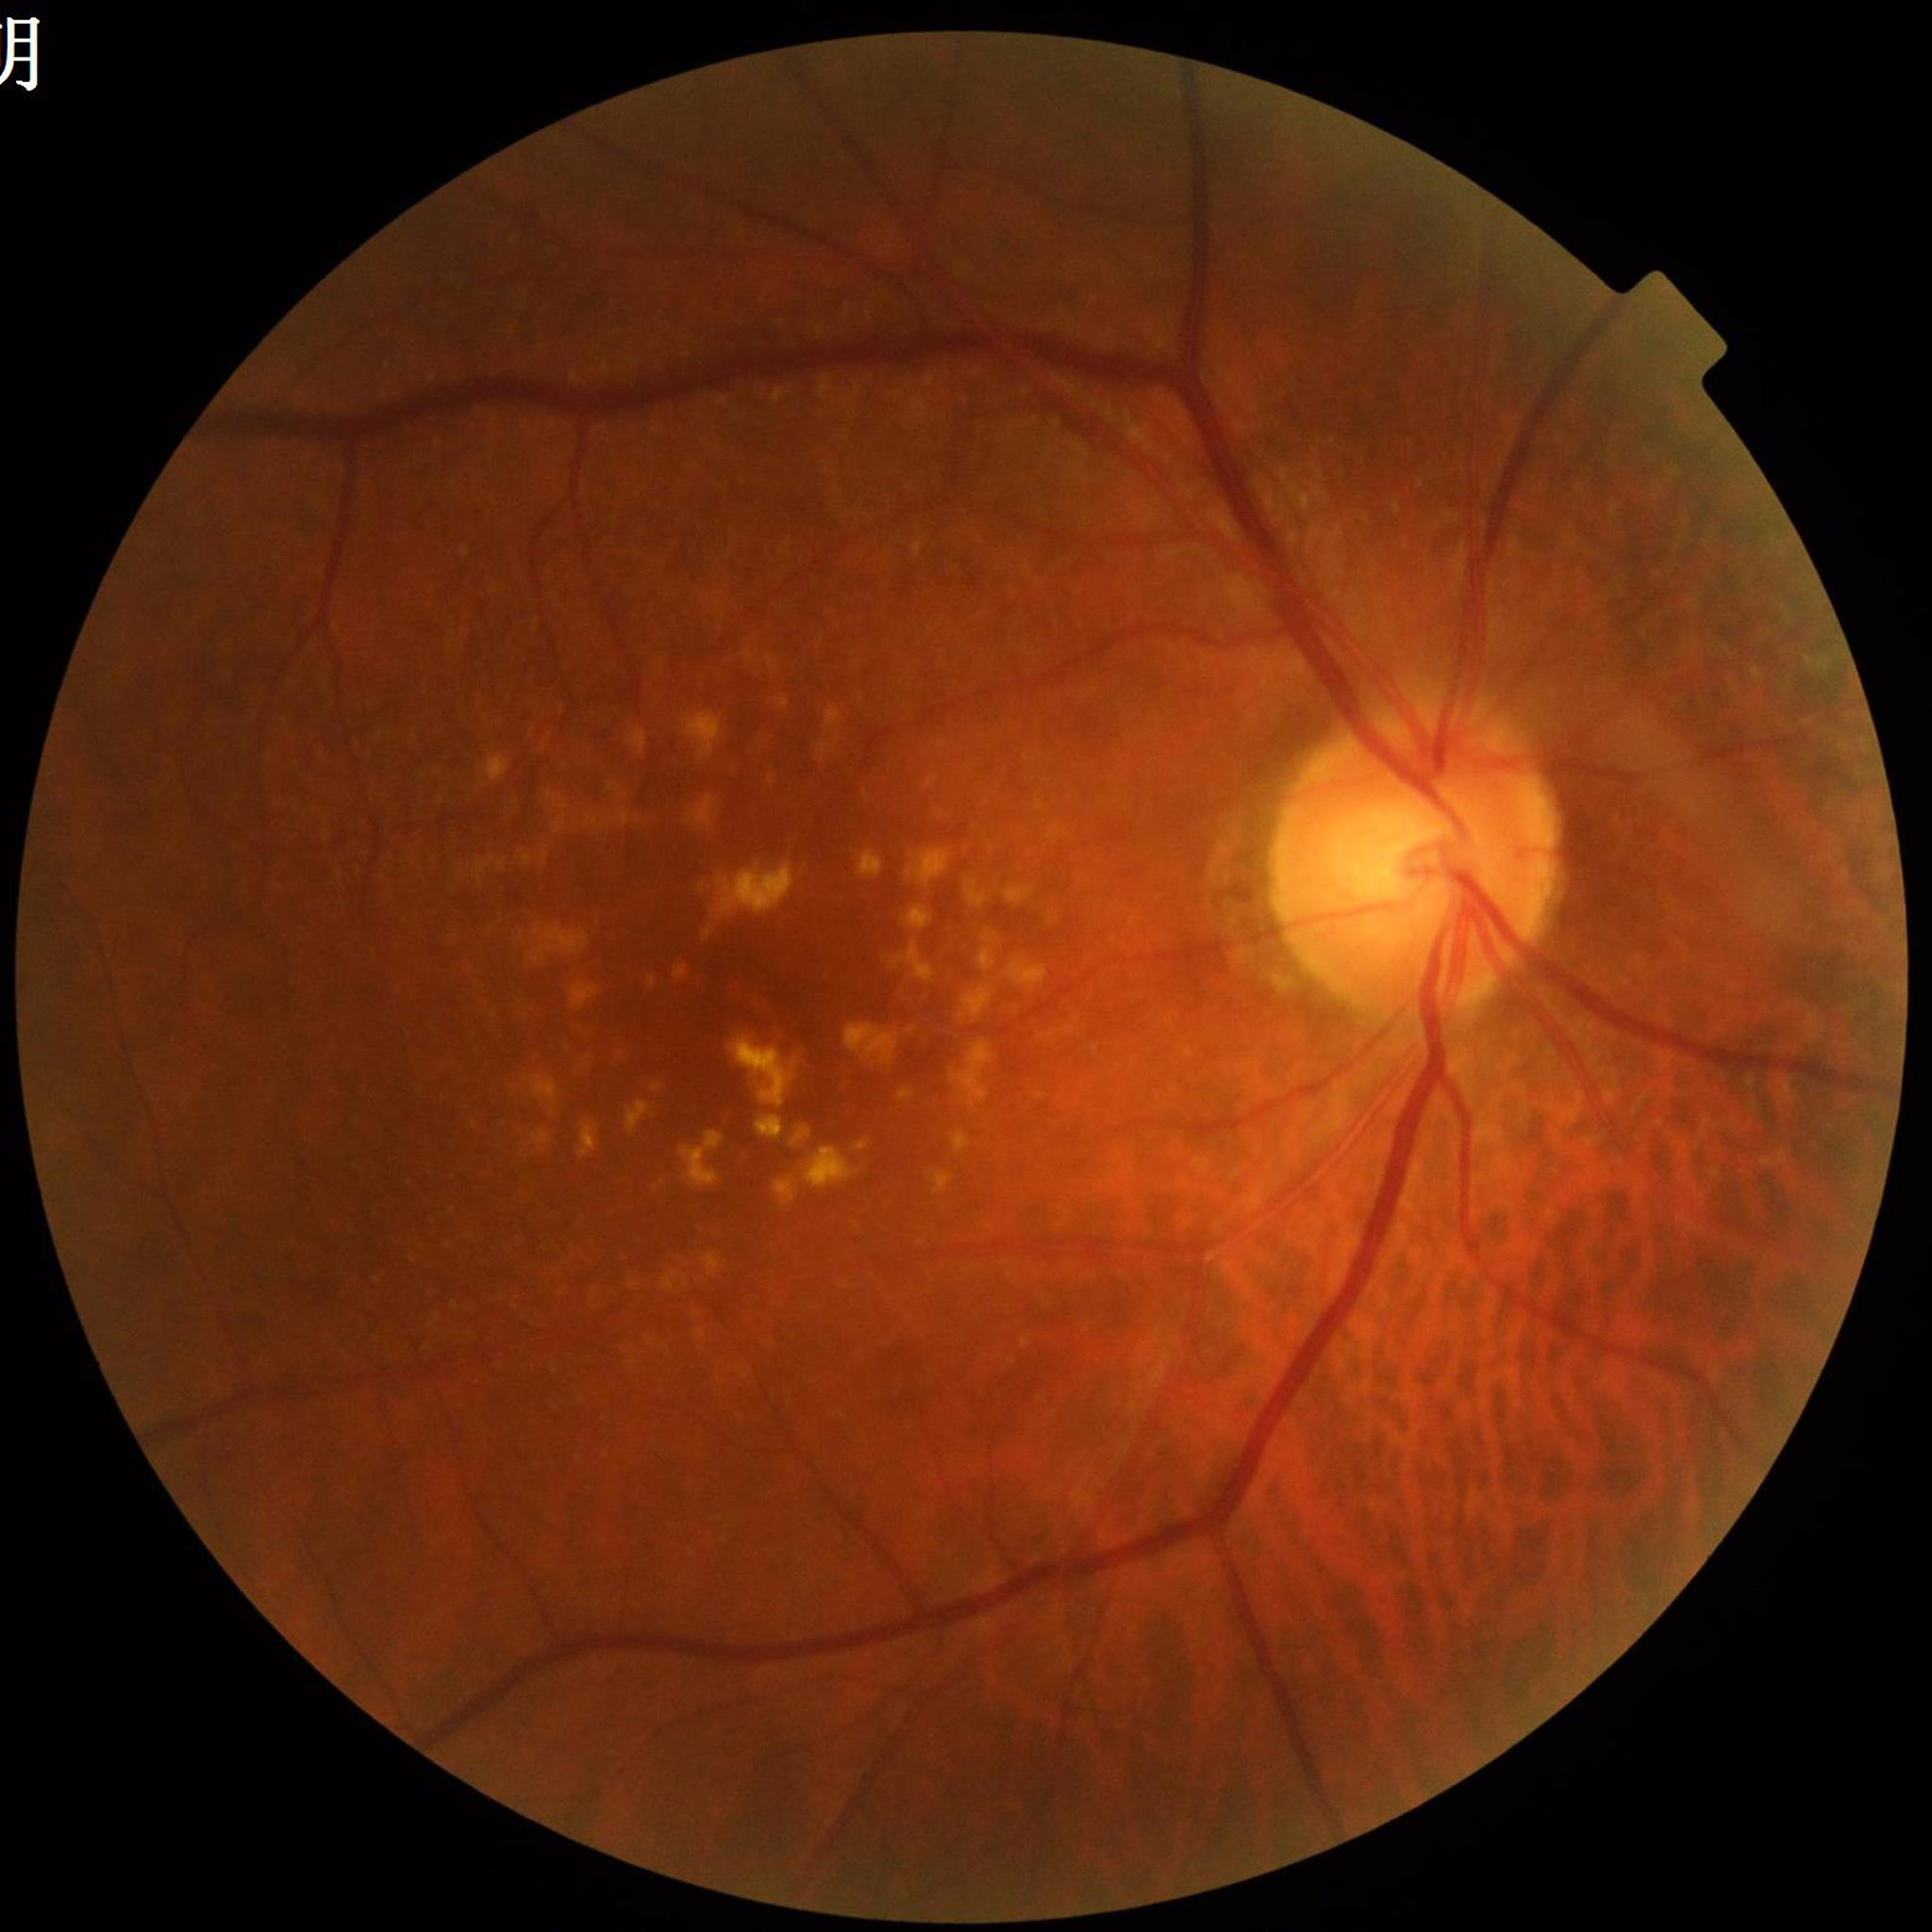
Disease = age-related macular degeneration (AMD).